2352 x 1568 pixels; 45° field of view; color fundus image:
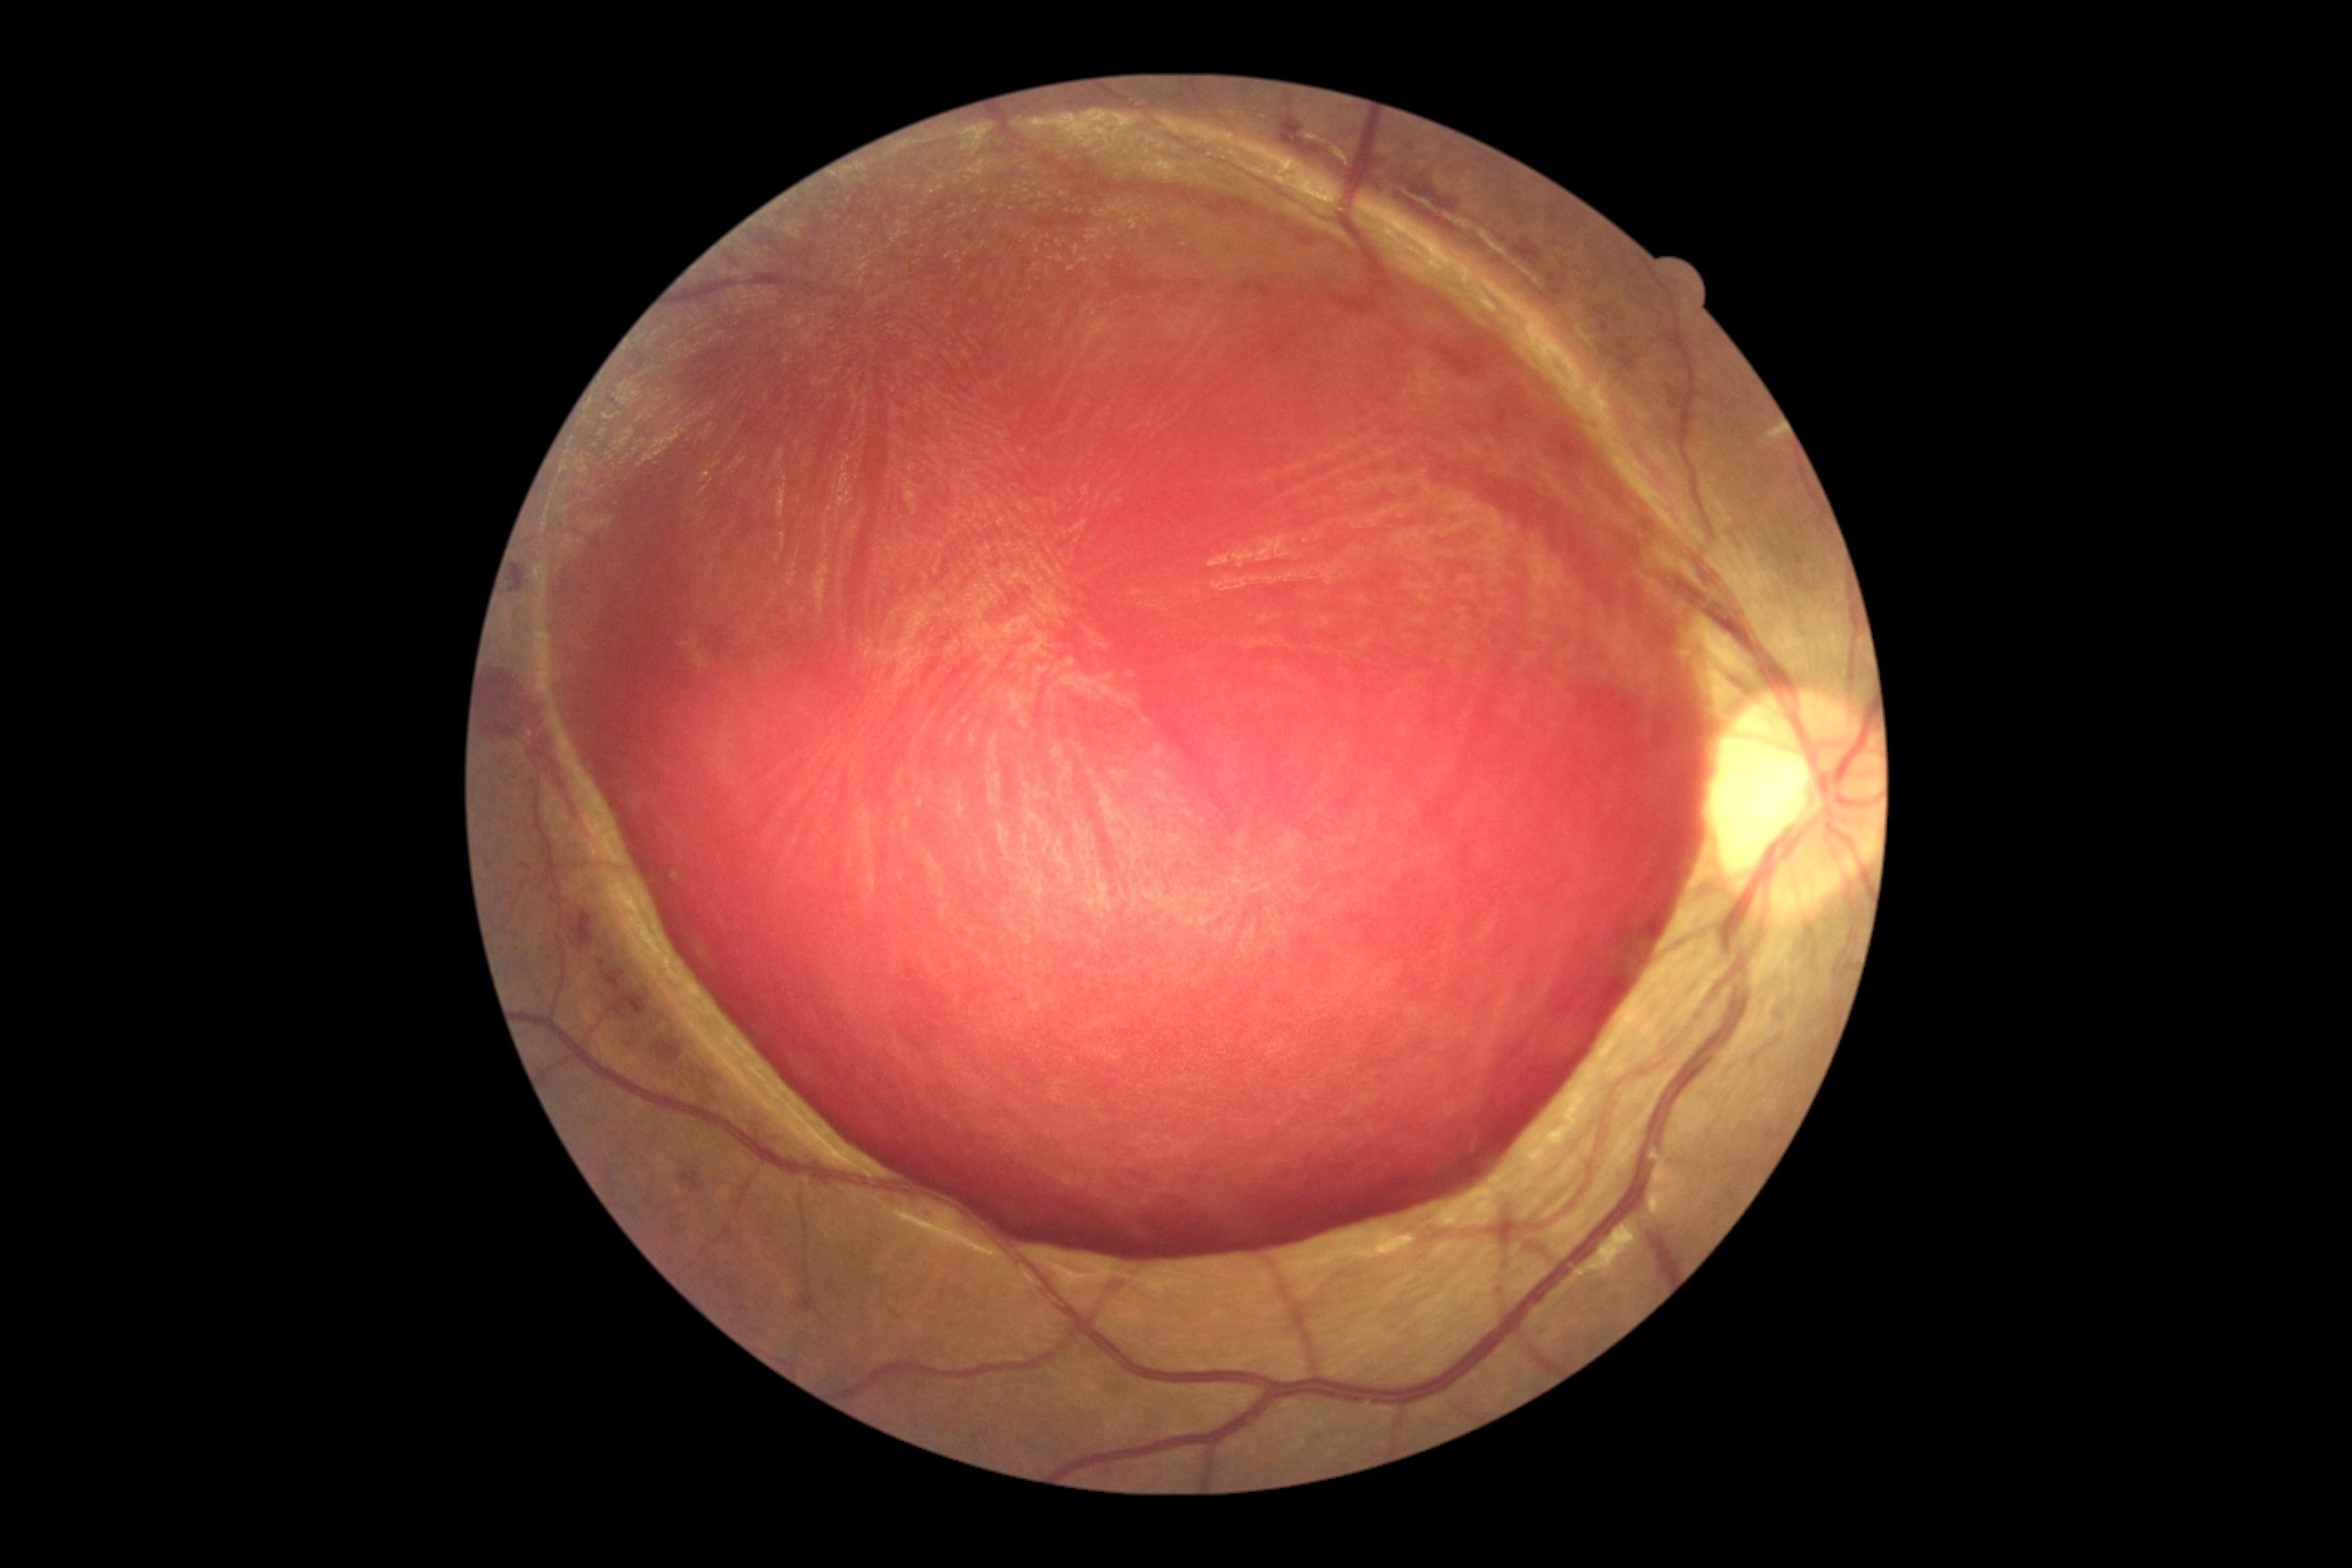

Diabetic retinopathy (DR): 4/4. DR class: proliferative diabetic retinopathy.